Clarity RetCam 3, 130° FOV; wide-field fundus photograph from neonatal ROP screening:
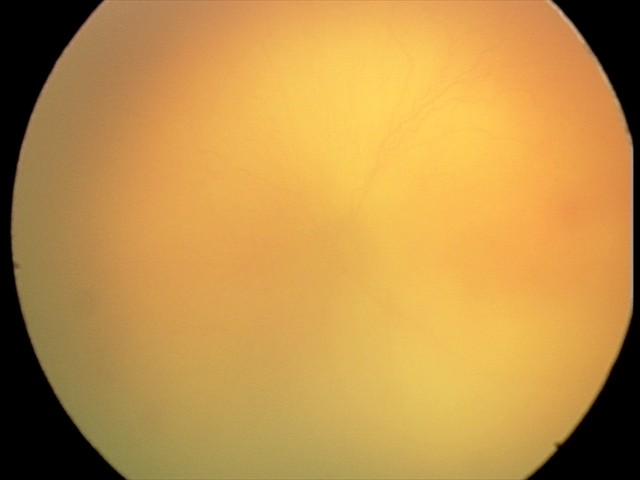 Q: What was the screening finding?
A: aggressive retinopathy of prematurity (A-ROP)
Q: Plus disease status?
A: plus disease — abnormal dilation and tortuosity of the posterior pole retinal vessels